2212 by 1659 pixels · FOV: 45 degrees:
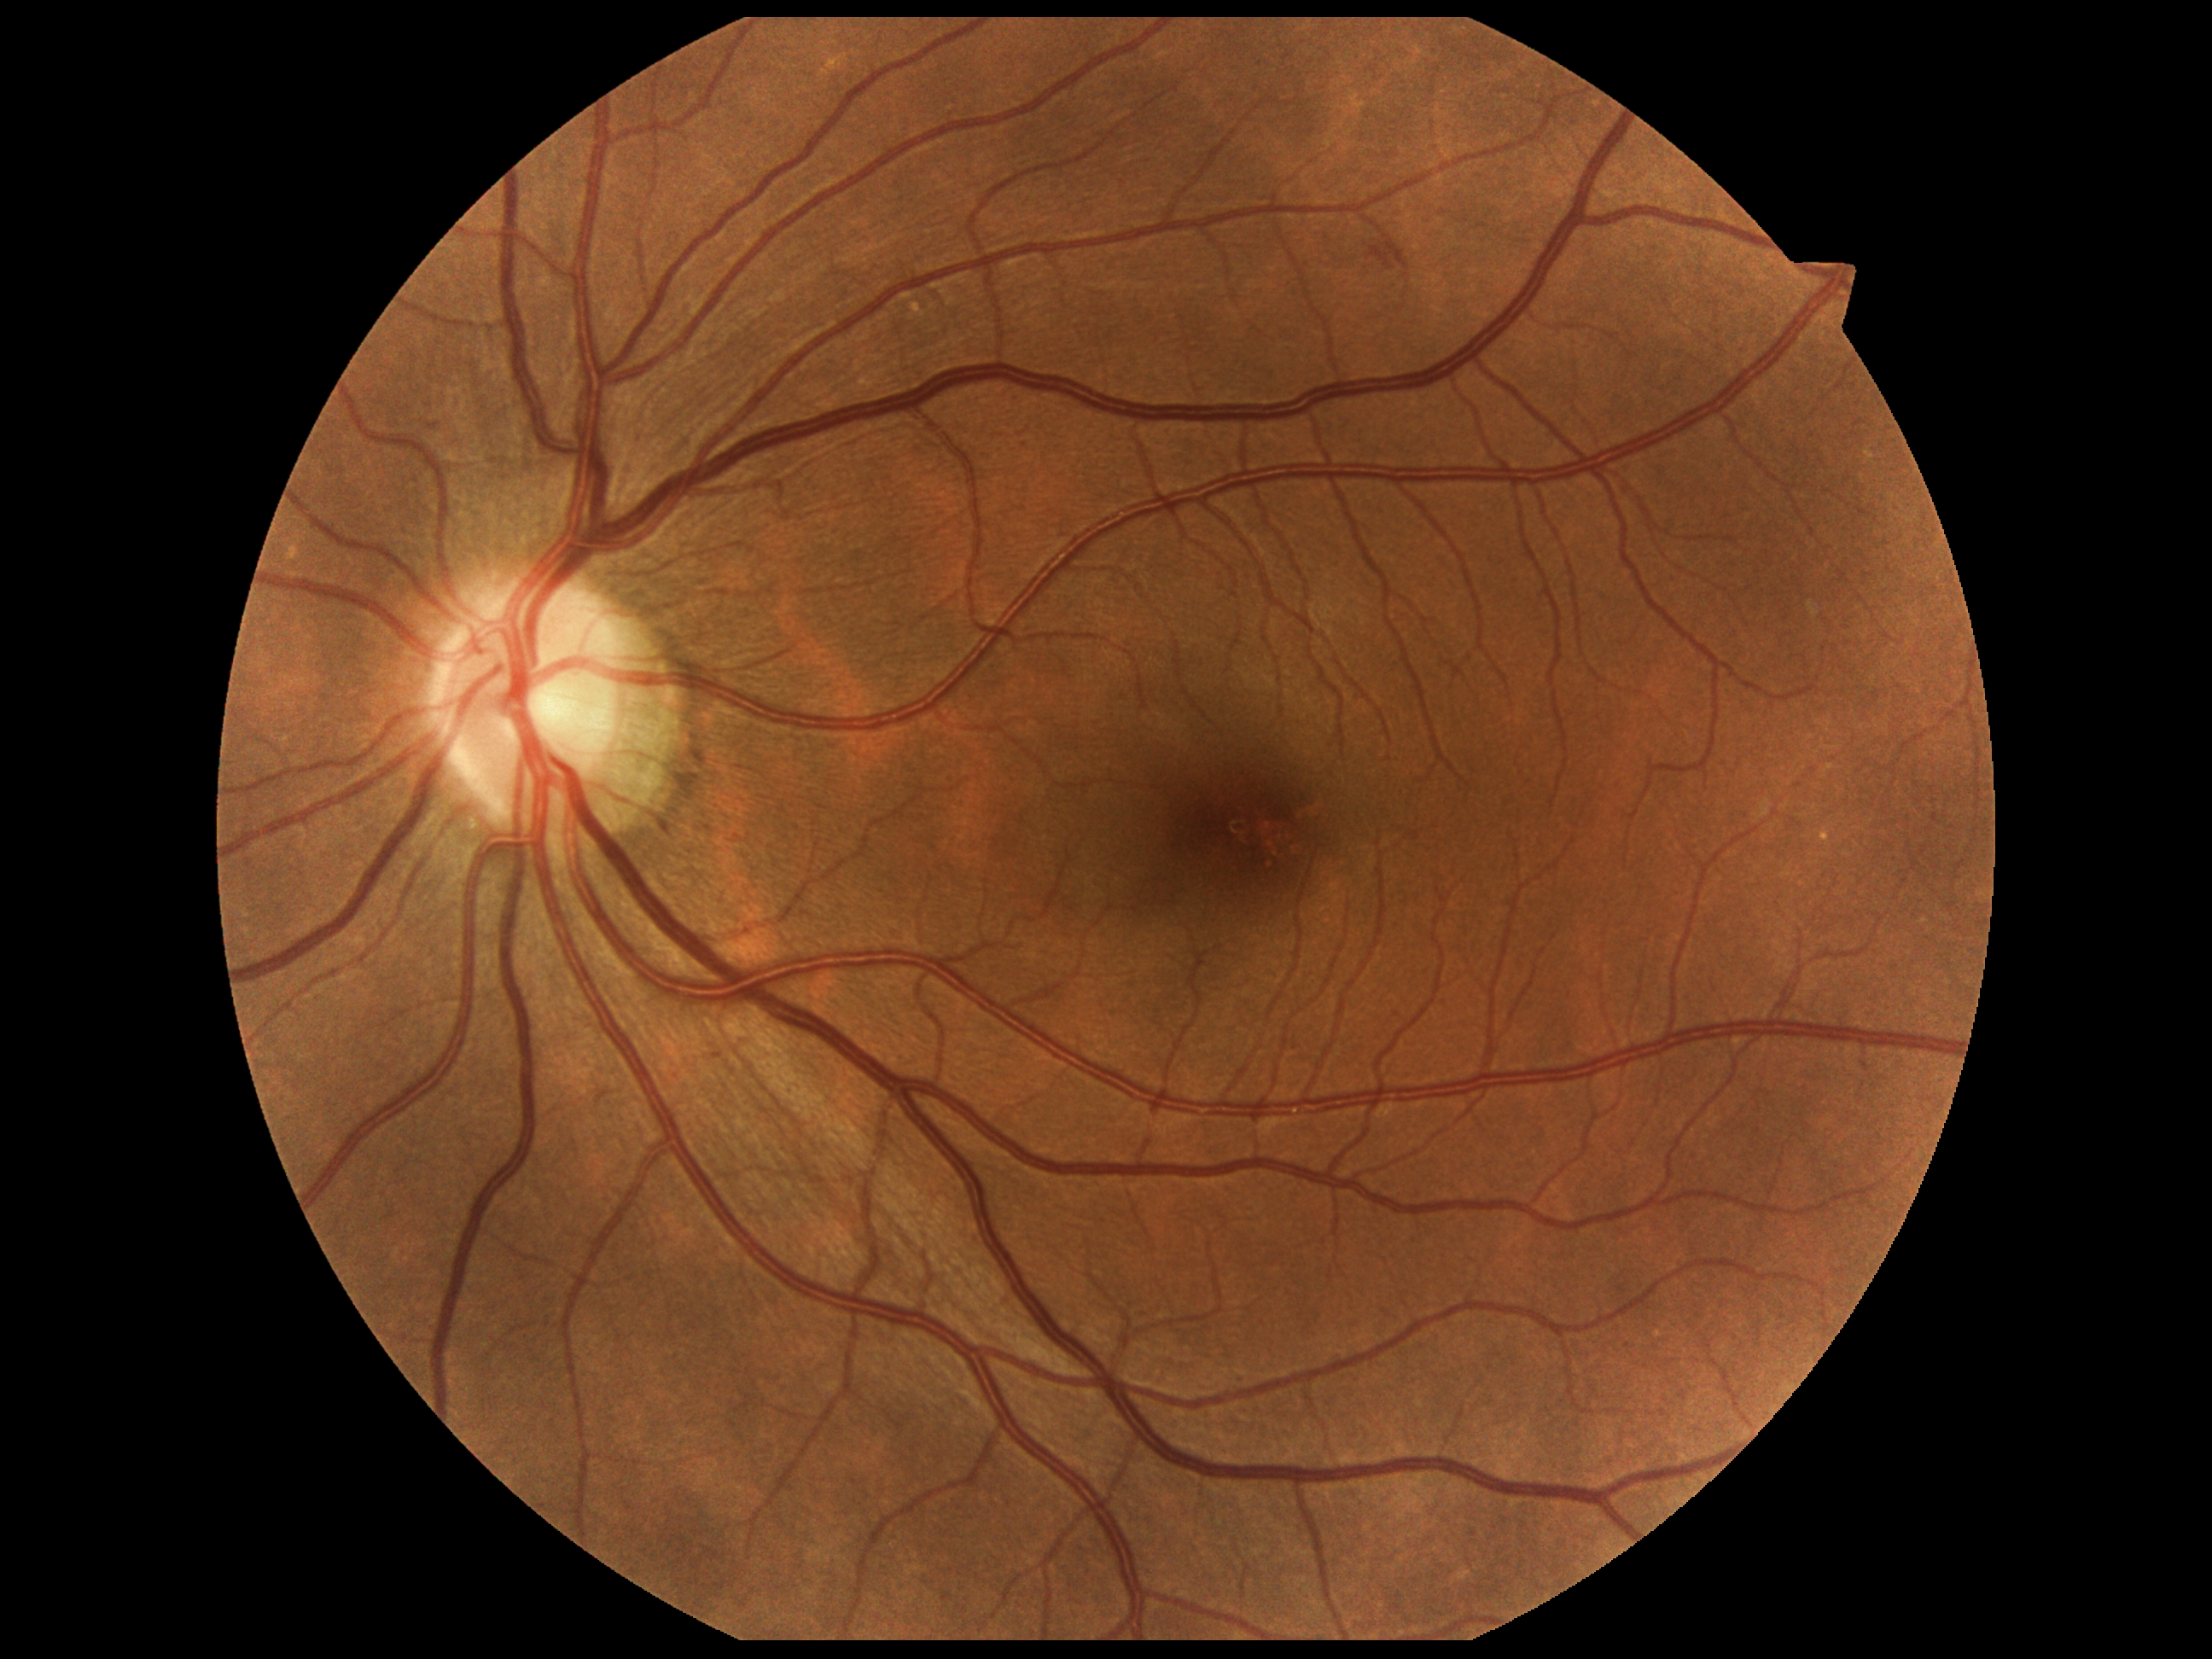 DR stage: 2.